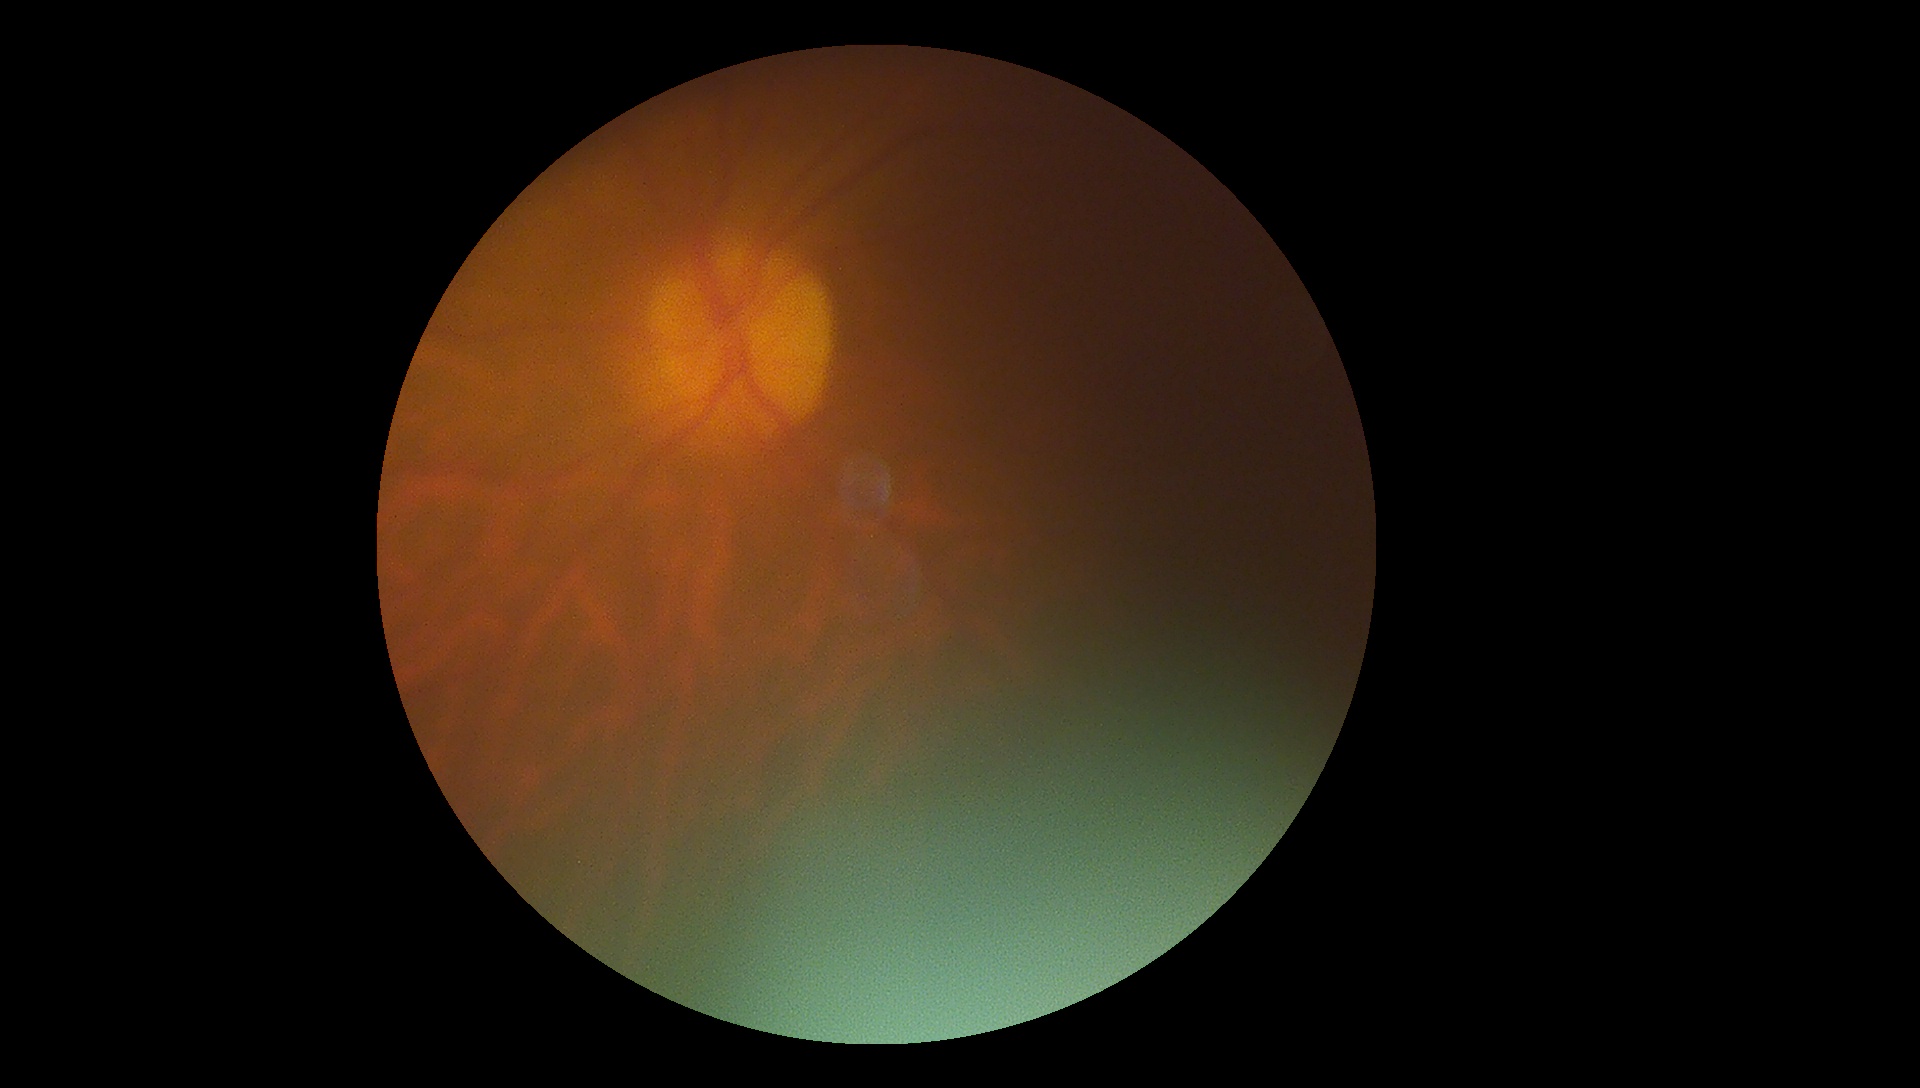 Ungradable image — DR severity cannot be determined.
Diabetic retinopathy: ungradable.